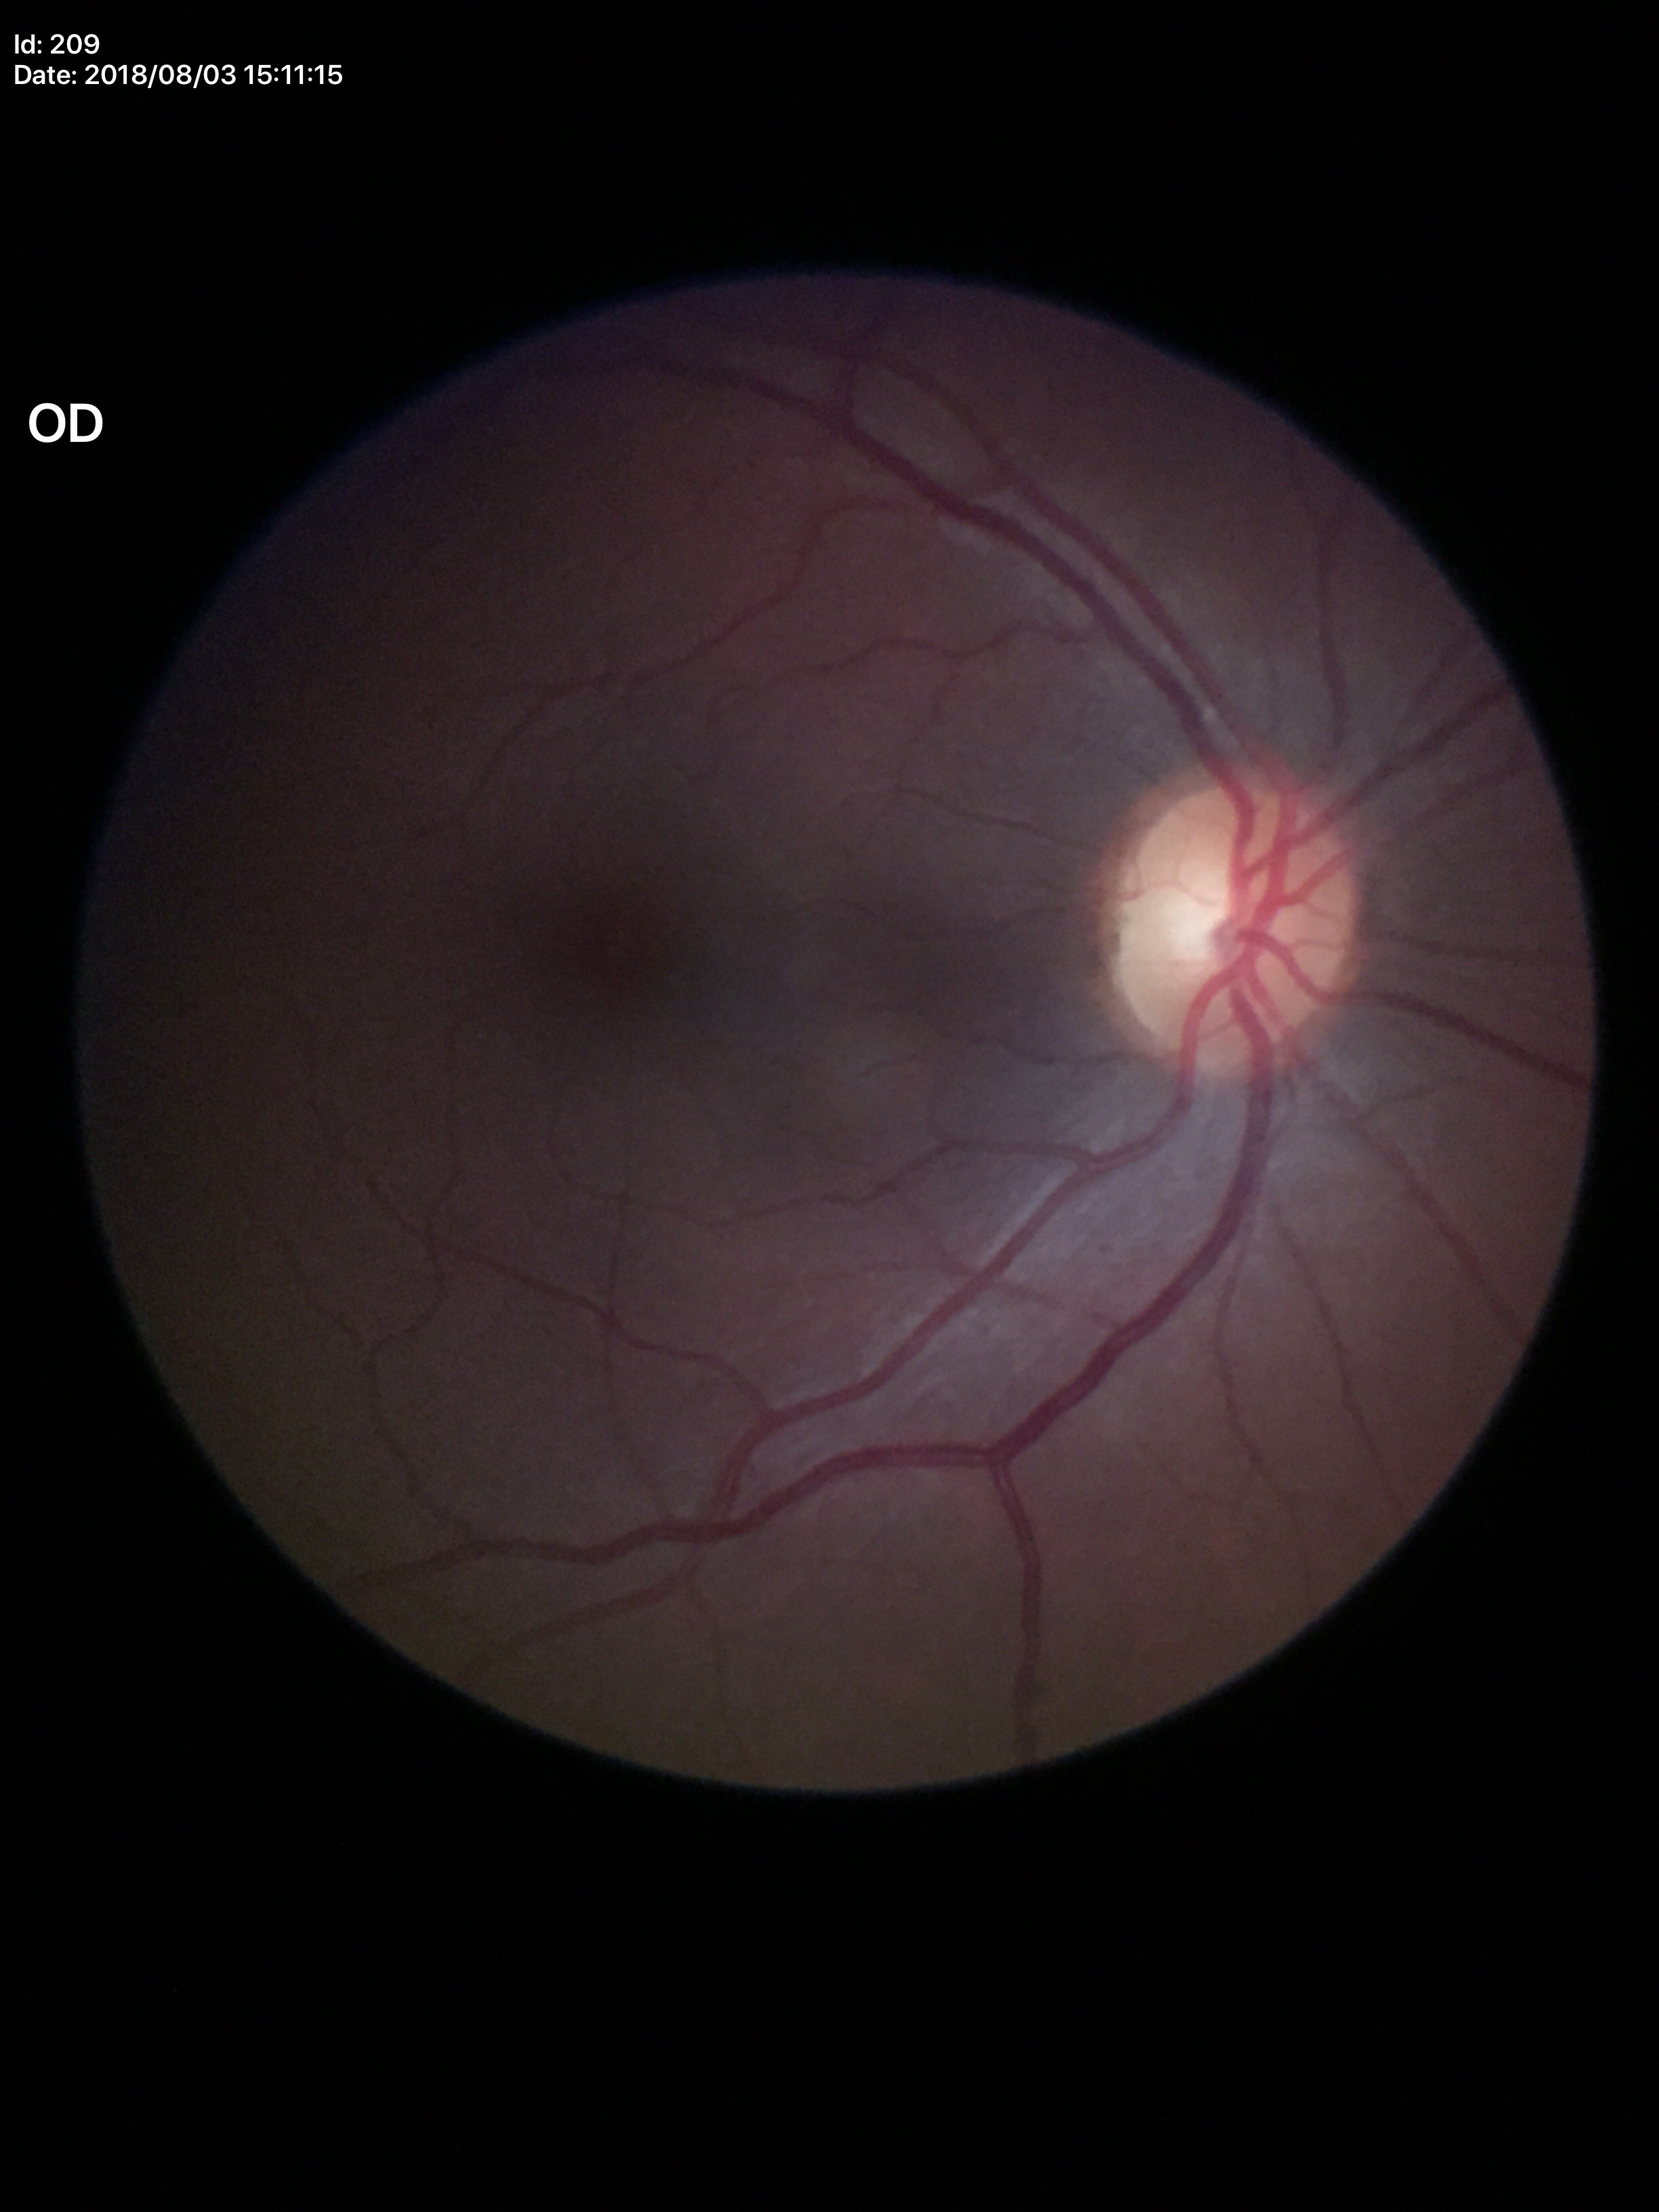
No signs of glaucoma. Vertical C/D ratio is 0.53.